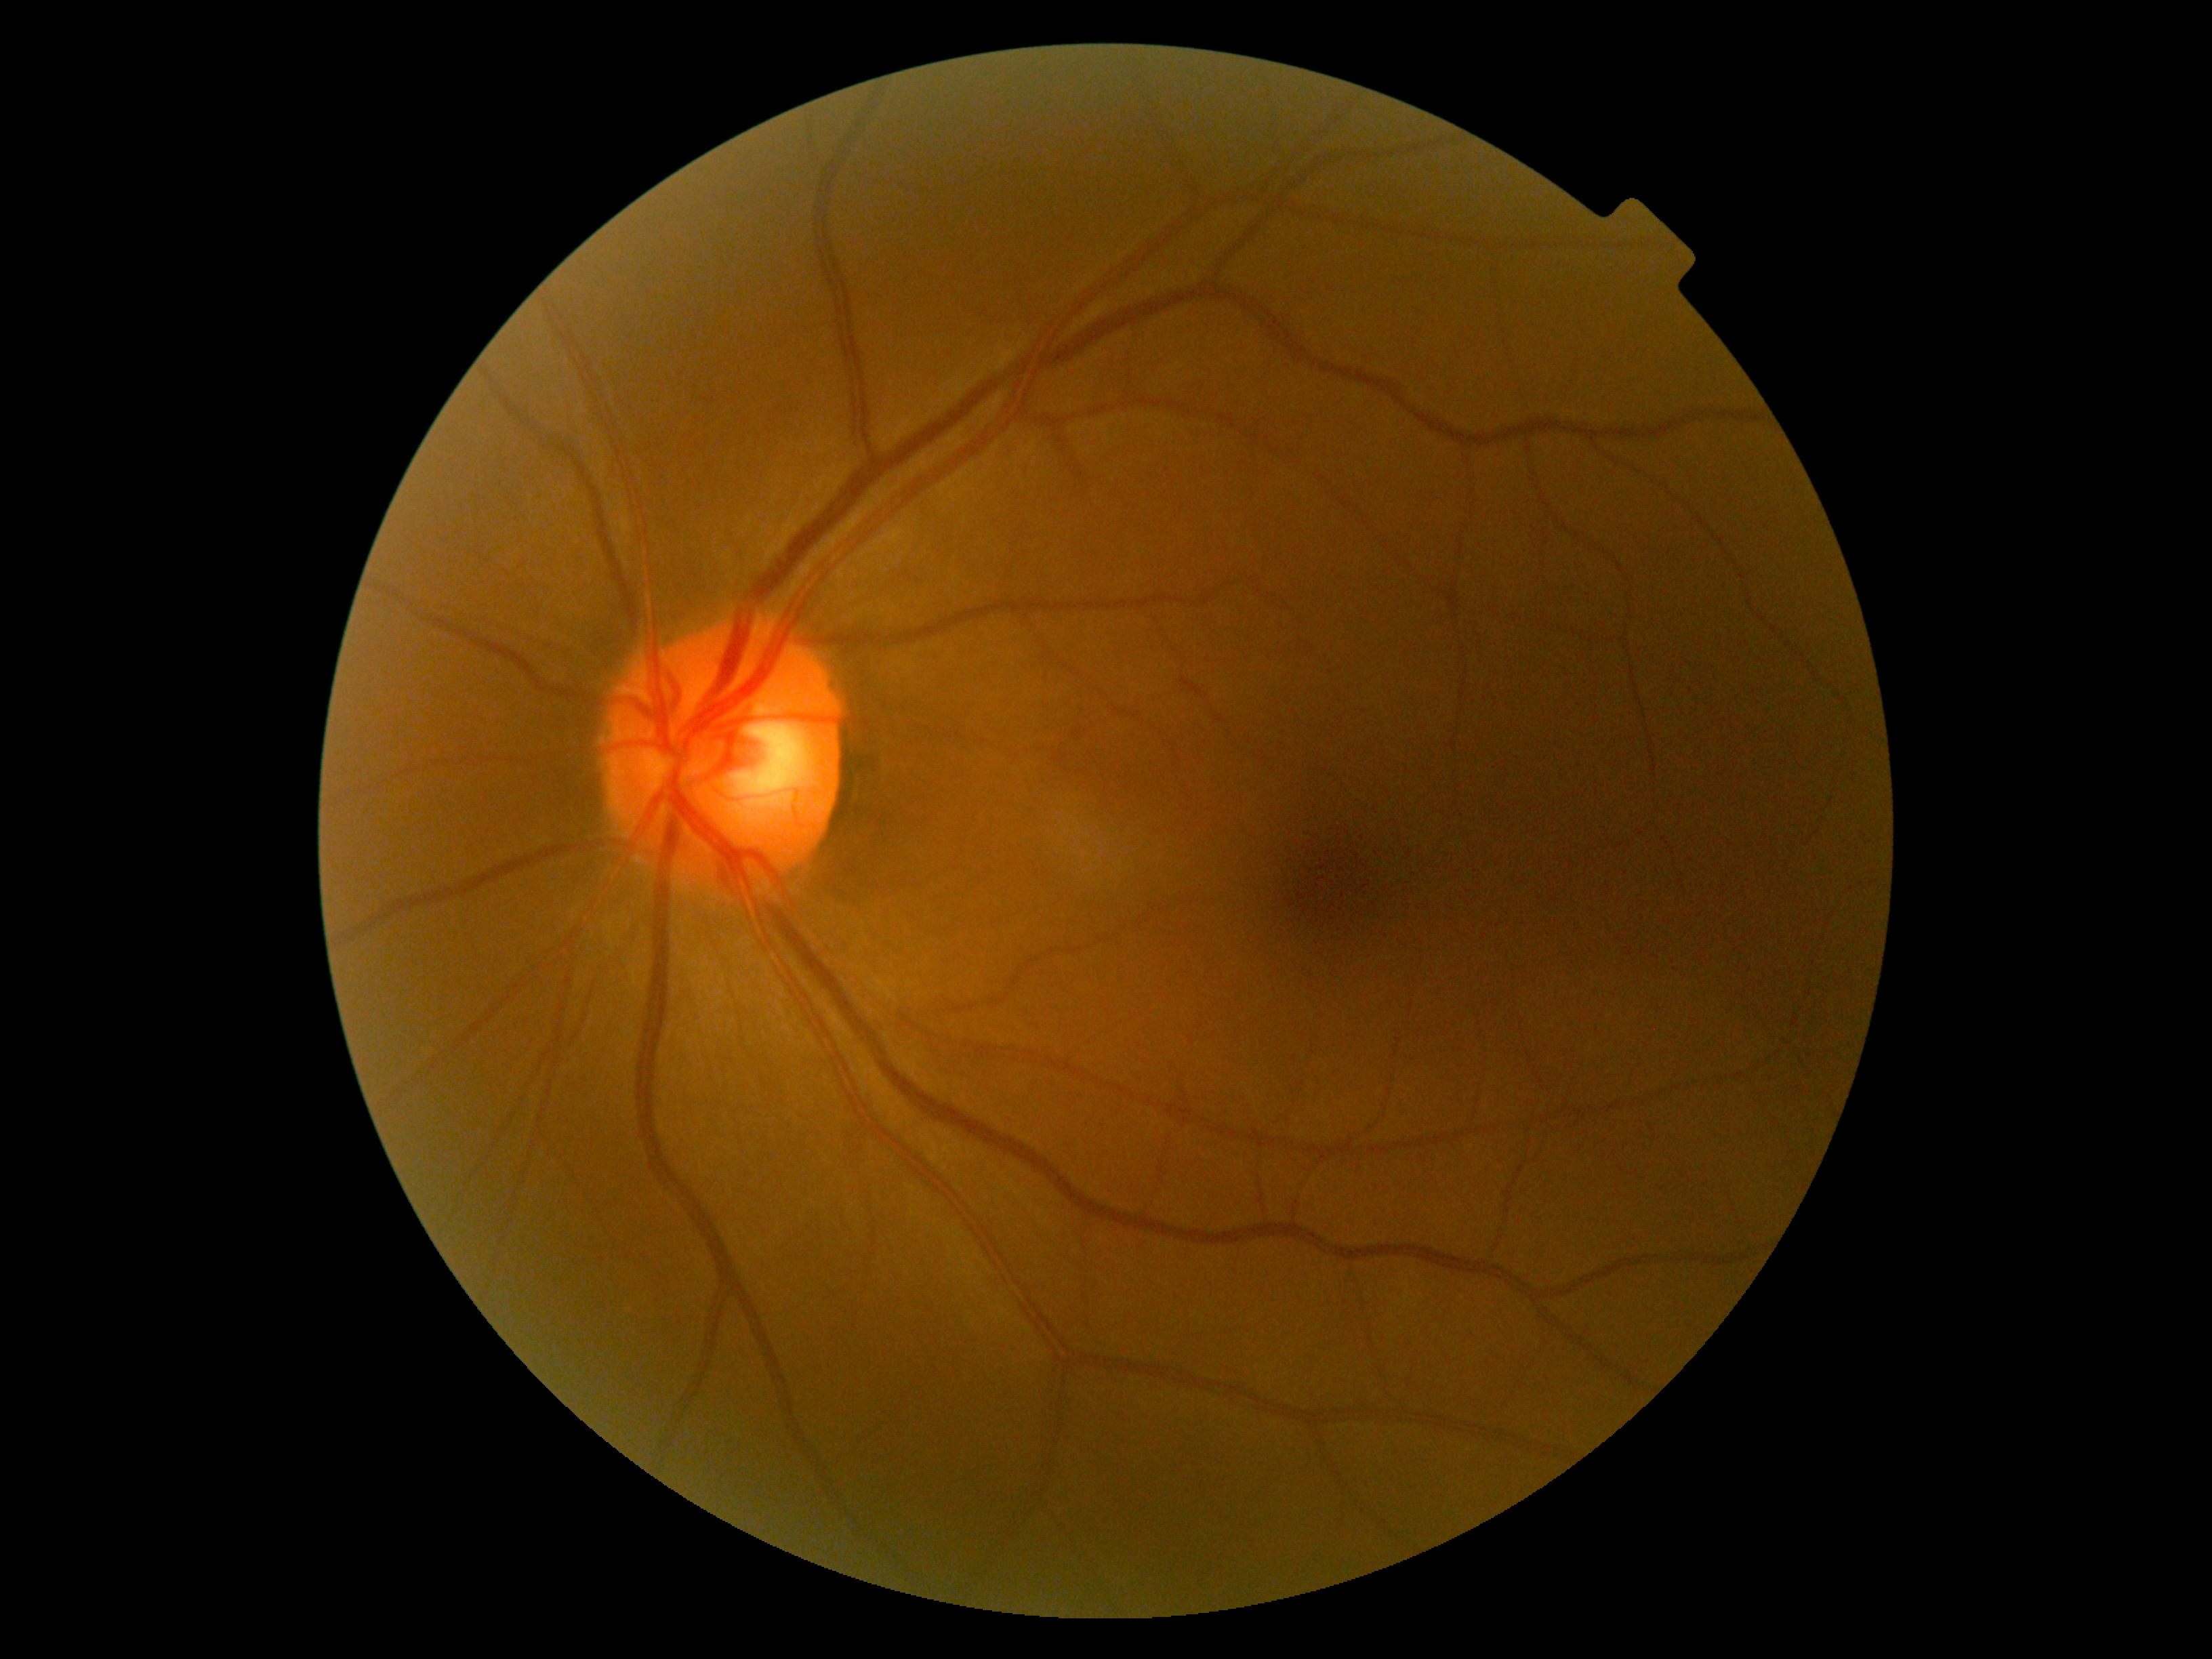 Retinopathy grade is 0 (no apparent retinopathy) — no visible signs of diabetic retinopathy.